Without pupil dilation. 45° FOV
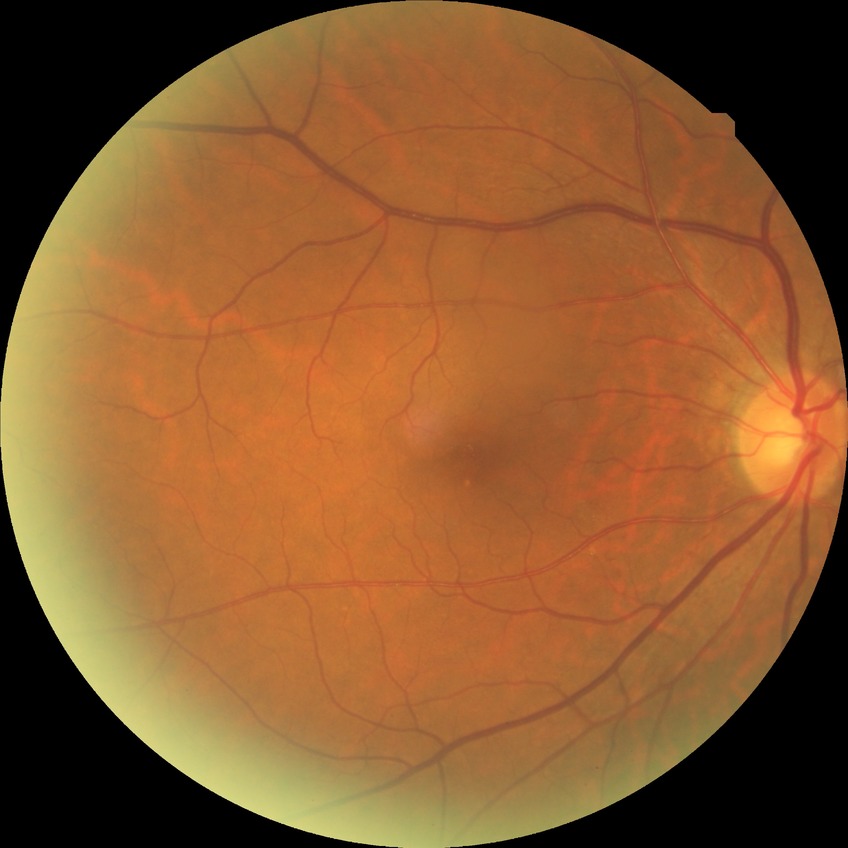

Retinopathy grade: no diabetic retinopathy.